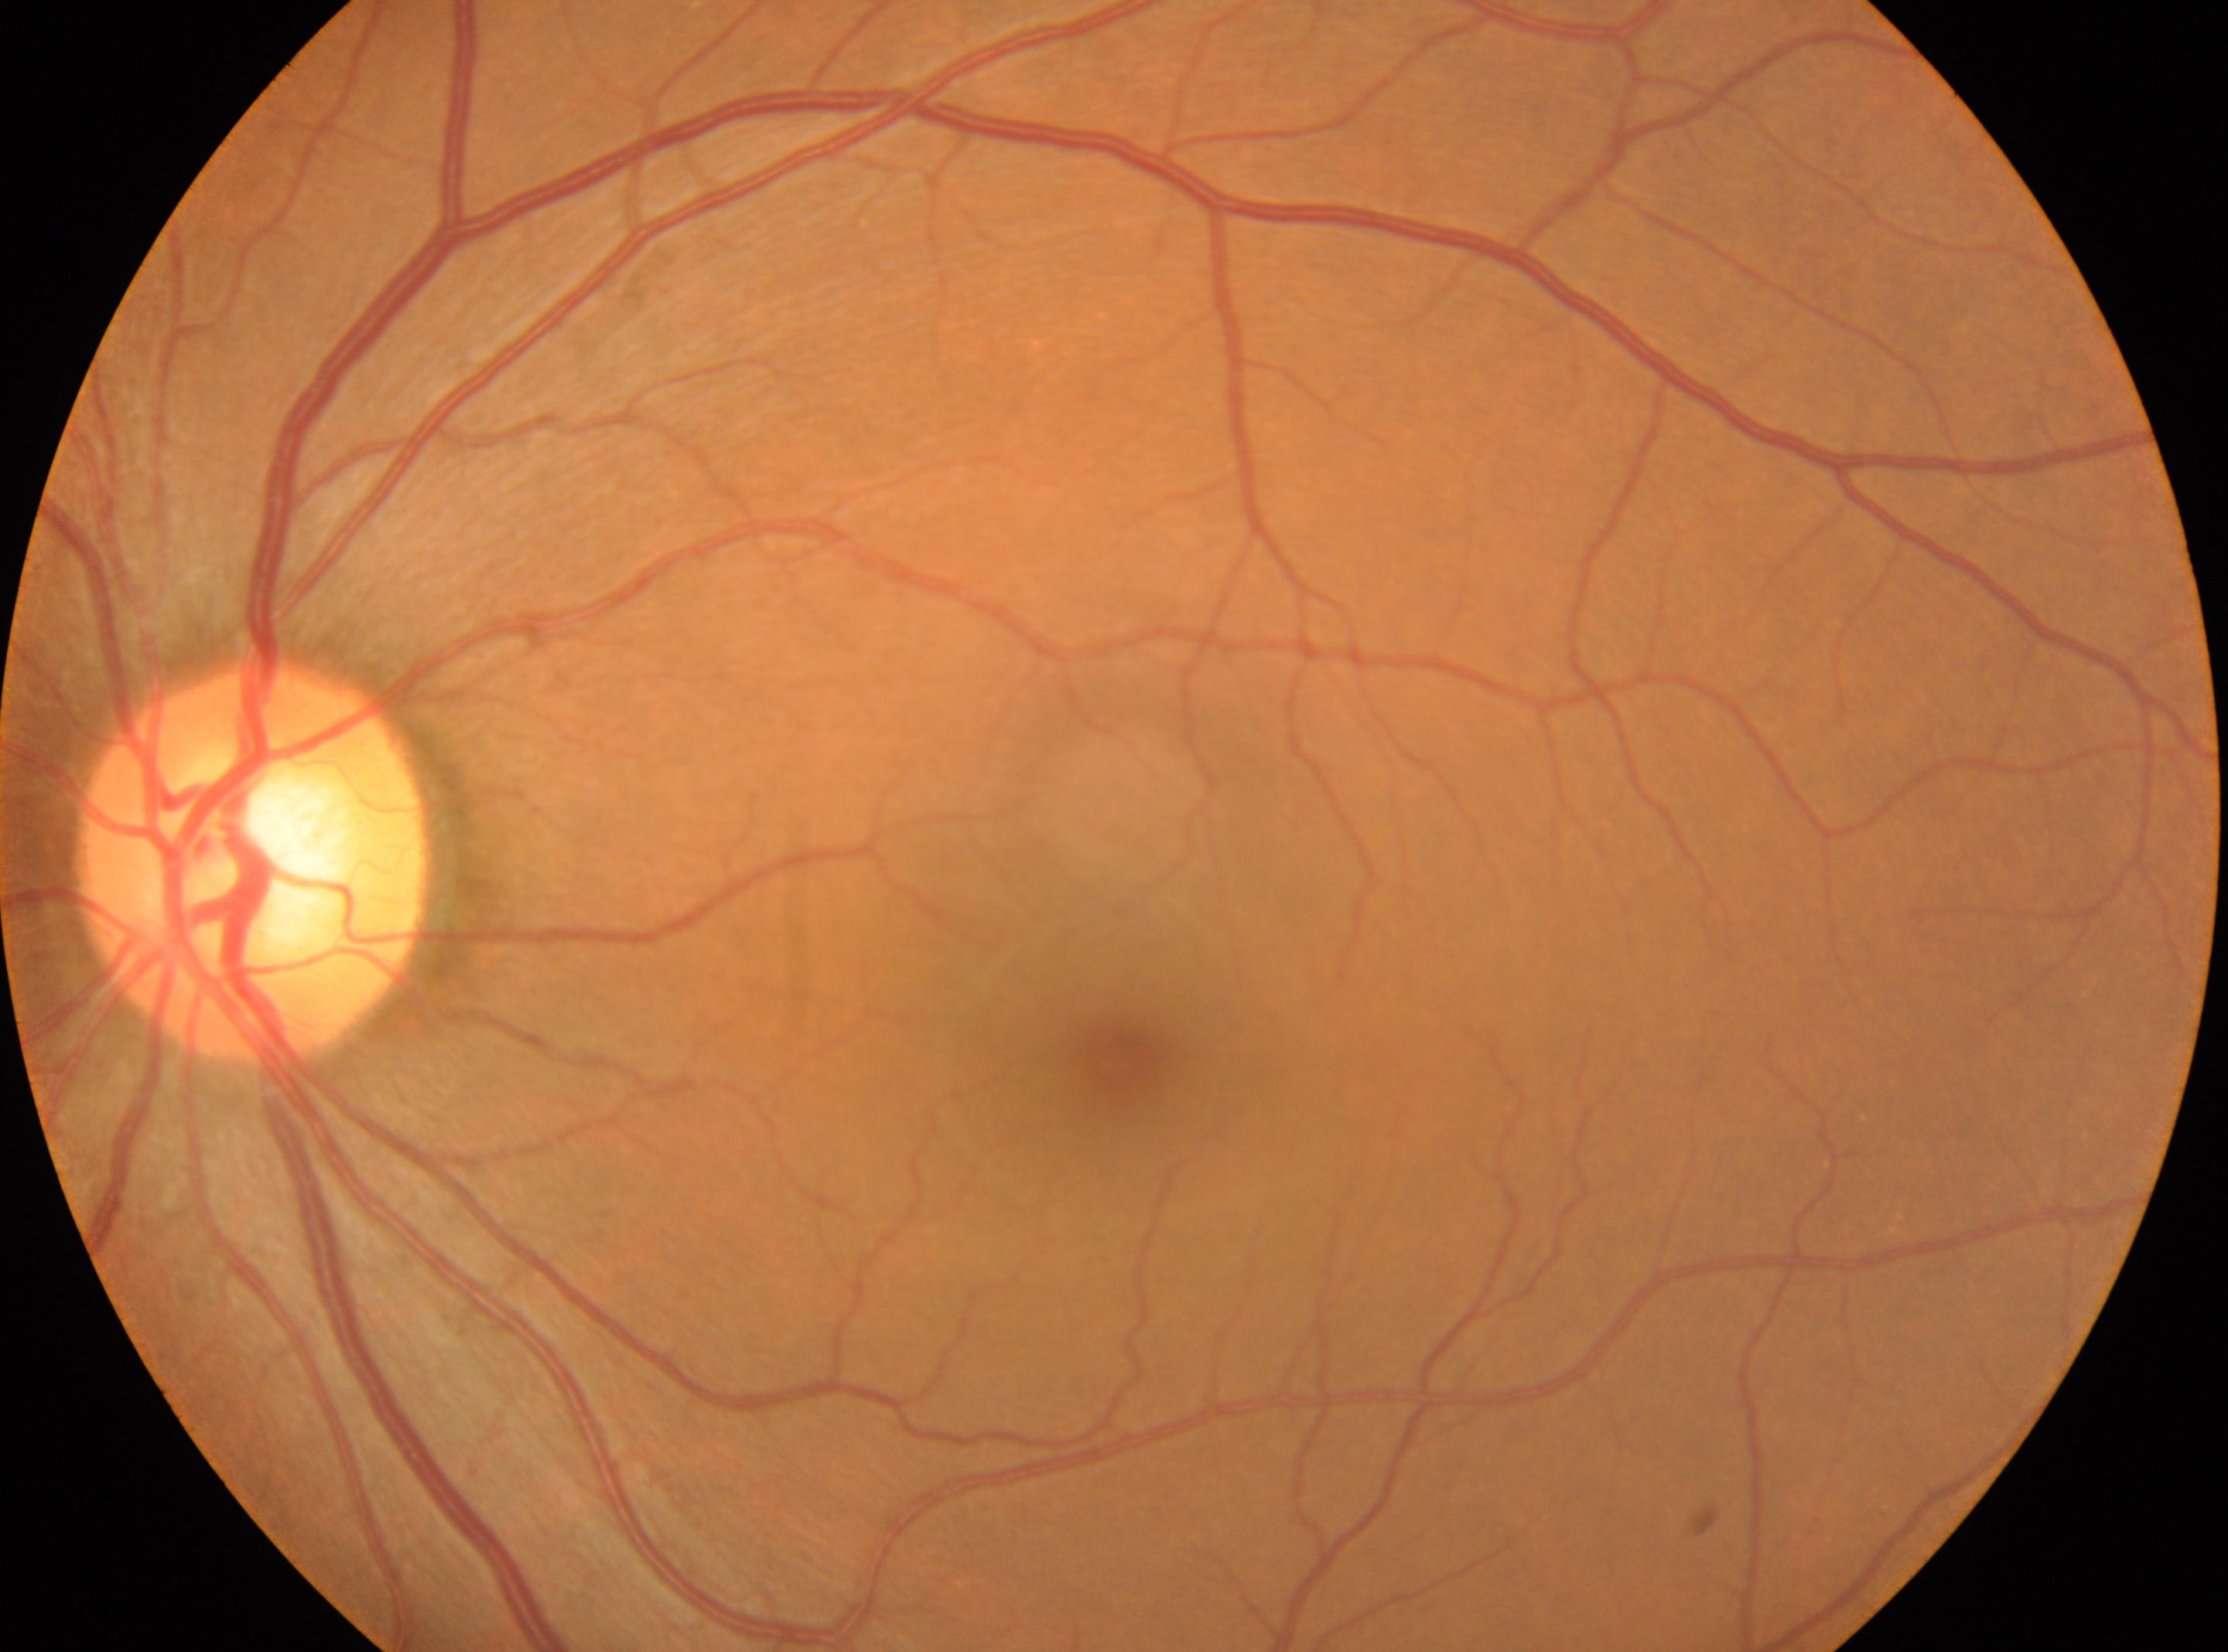
ONH: (x=252, y=867).
Fovea located at (x=1116, y=1058).
No apparent diabetic retinopathy.
Diabetic retinopathy grade is 0 (no apparent retinopathy).
This is the oculus sinister.